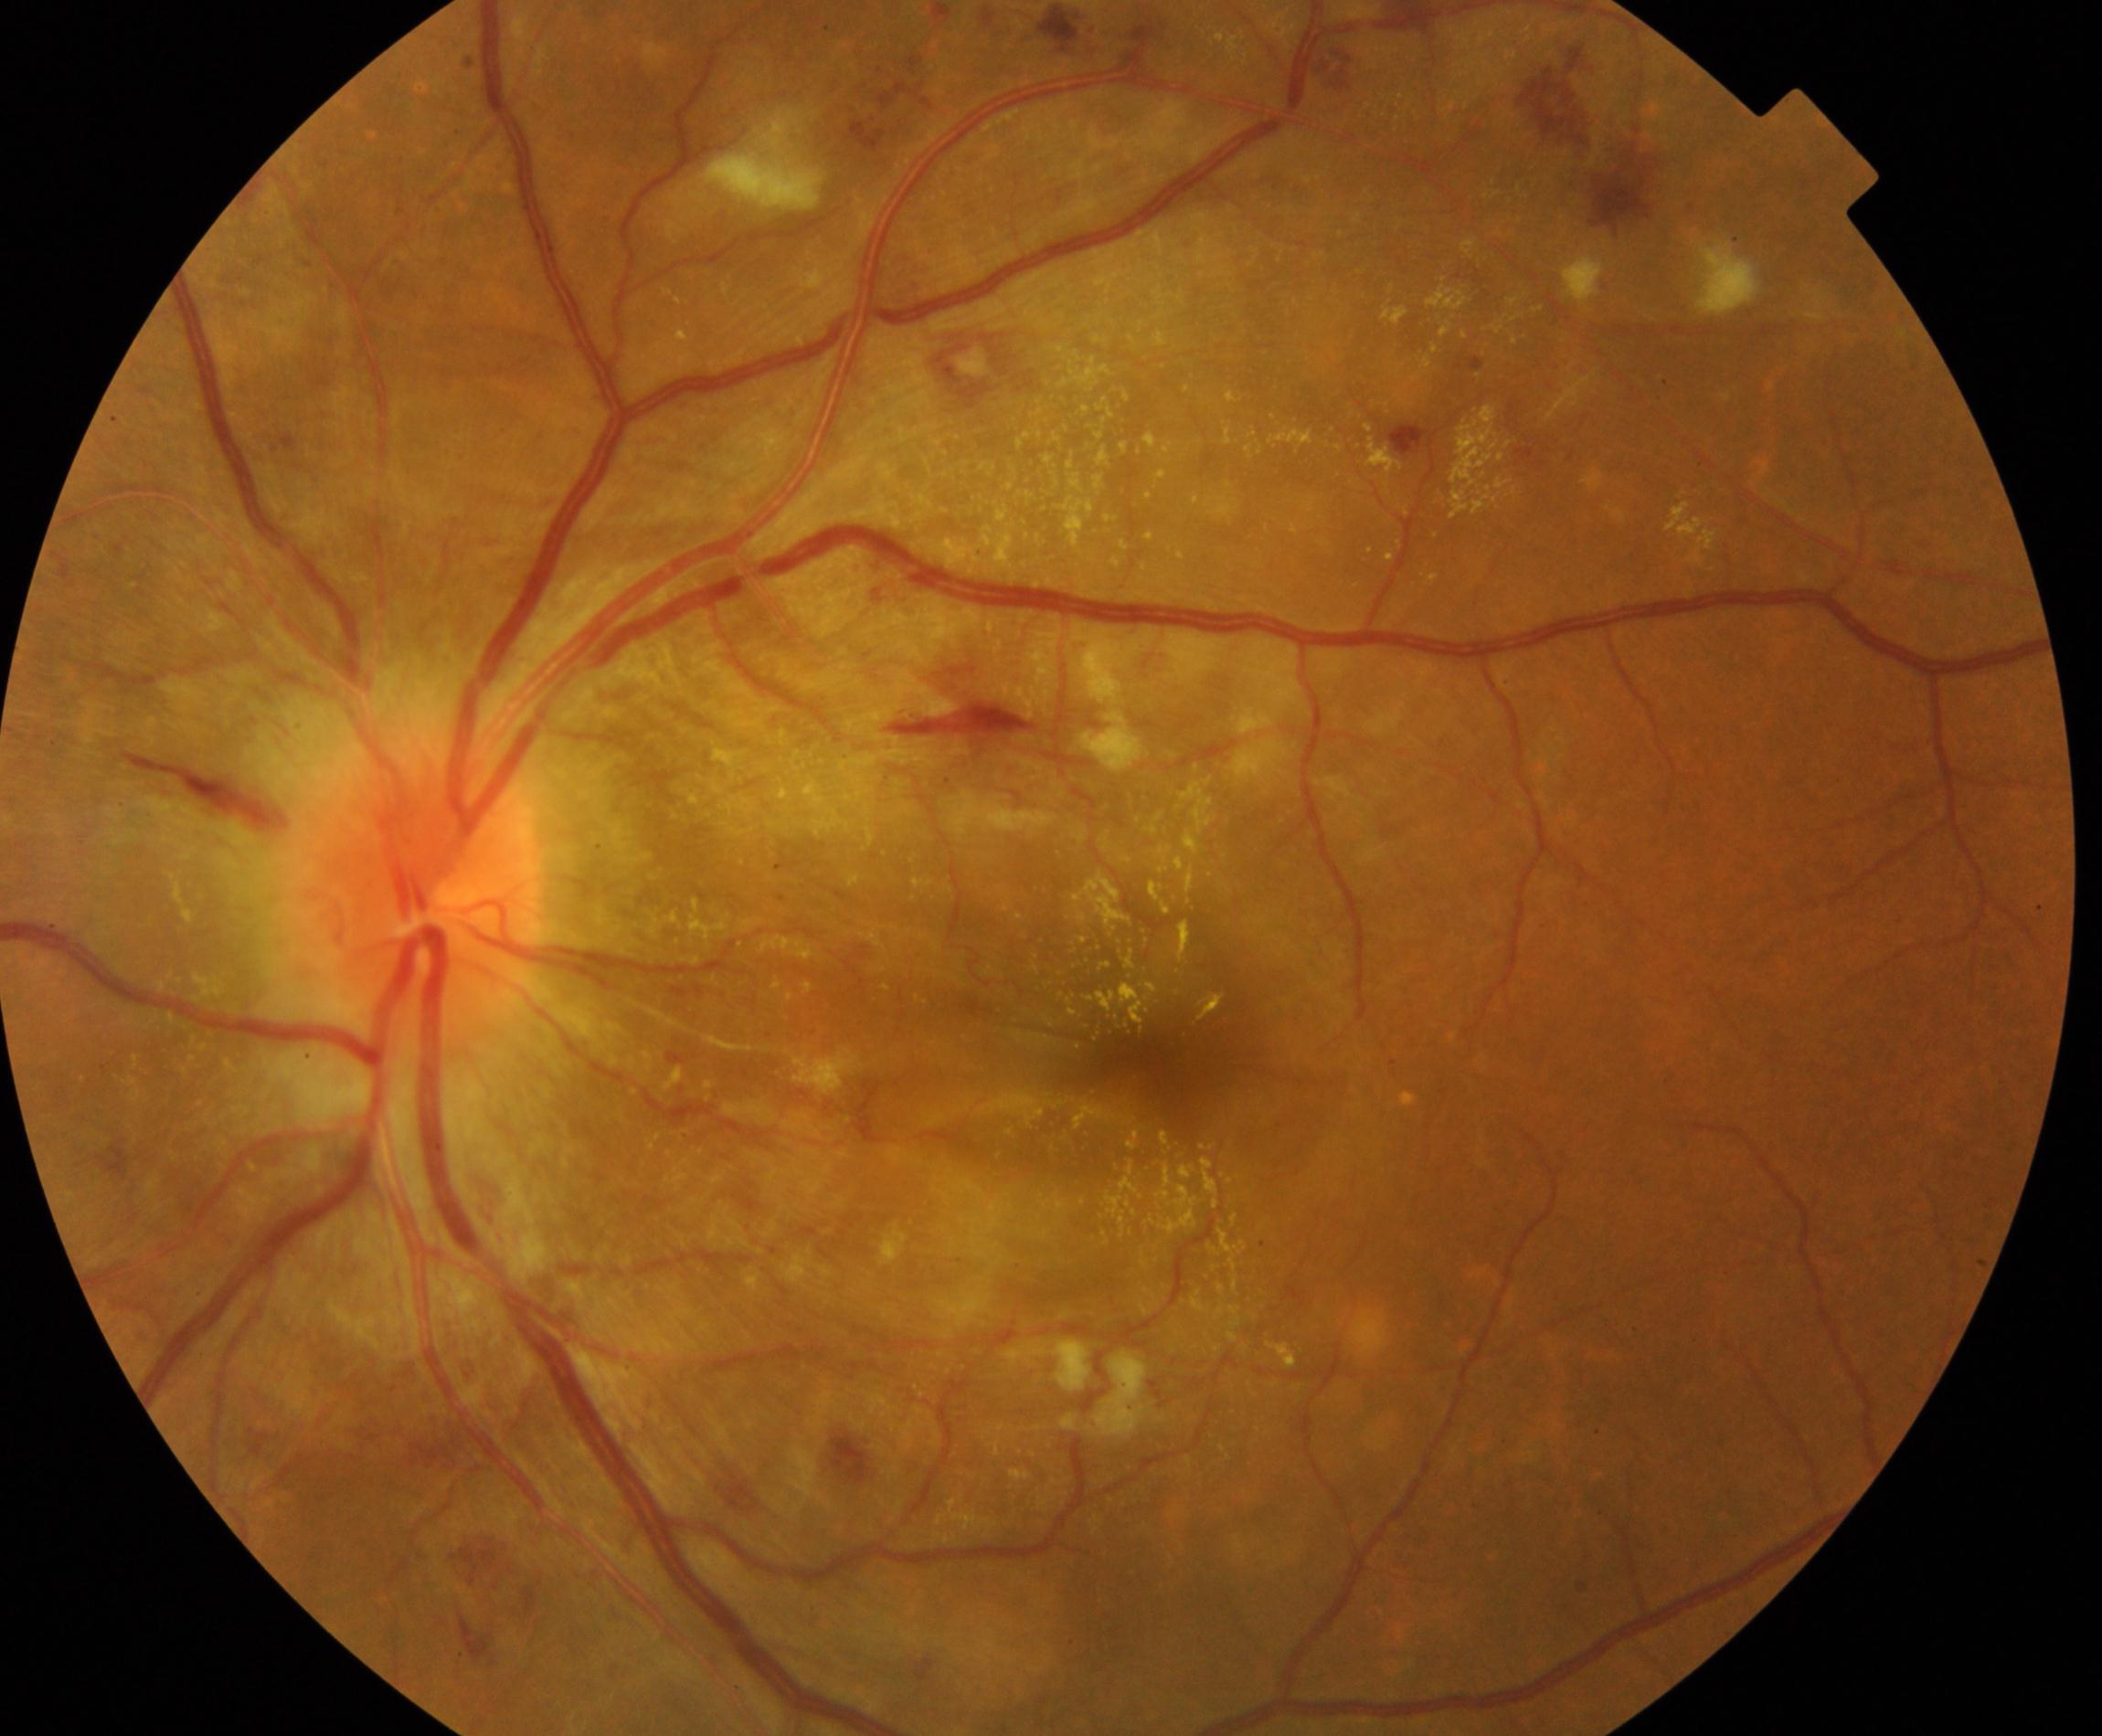

Findings consistent with severe hypertensive retinopathy.